CFP — 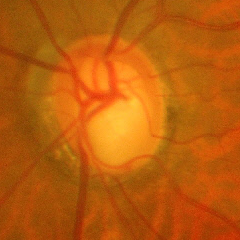 The image shows severe glaucomatous damage.